Optic disc region of a color fundus photo — 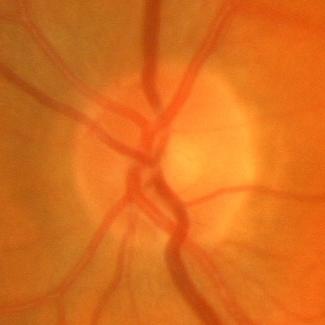
Q: What is the glaucoma diagnosis?
A: No — no glaucomatous findings.